2352 x 1568 pixels: 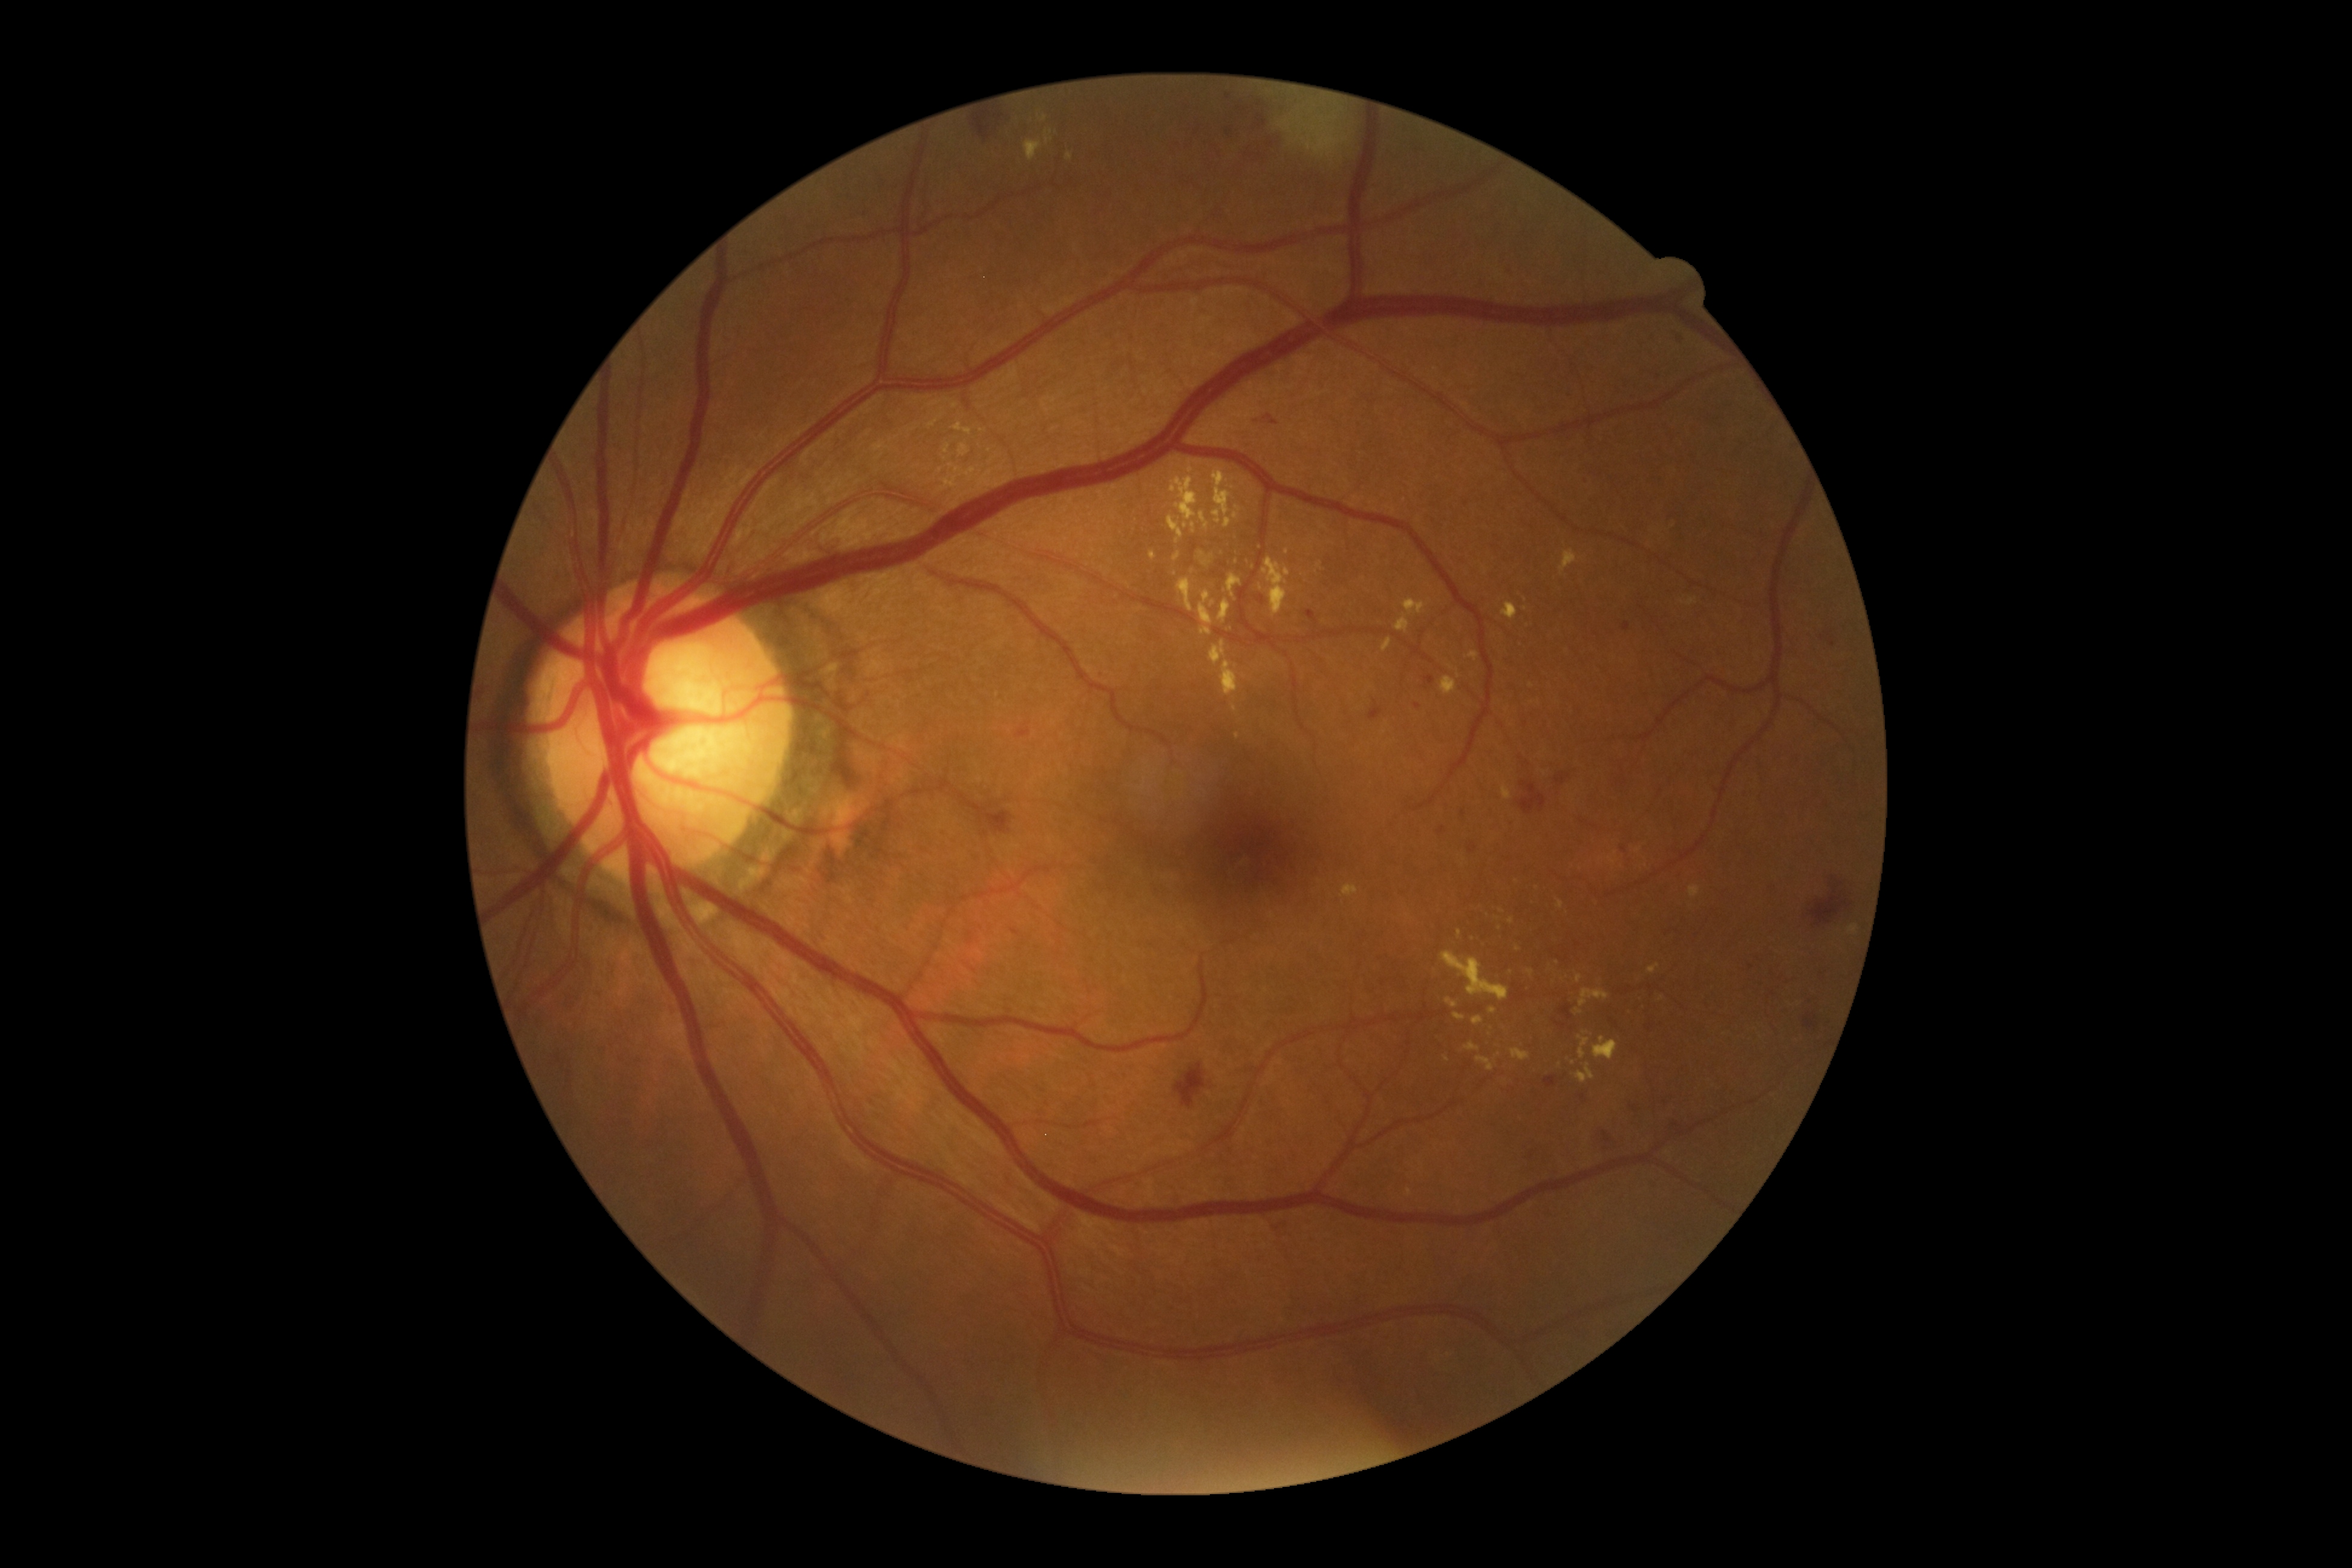
partial: true
dr_grade: 2
lesions:
  ex:
    - bbox=[1475, 1057, 1497, 1071]
    - bbox=[1847, 924, 1859, 936]
    - bbox=[1511, 1048, 1530, 1060]
    - bbox=[1445, 998, 1457, 1007]
    - bbox=[1573, 1063, 1595, 1082]
    - bbox=[1593, 1037, 1618, 1060]
    - bbox=[1191, 522, 1196, 533]
    - bbox=[1396, 598, 1427, 632]
    - bbox=[1687, 597, 1696, 606]
    - bbox=[1150, 551, 1157, 560]
  ex_small:
    - (x=1287, y=552)
    - (x=1510, y=971)
    - (x=1233, y=487)
    - (x=1517, y=948)
    - (x=1579, y=1010)
    - (x=940, y=471)